RetCam wide-field infant fundus image · 640 x 480 pixels:
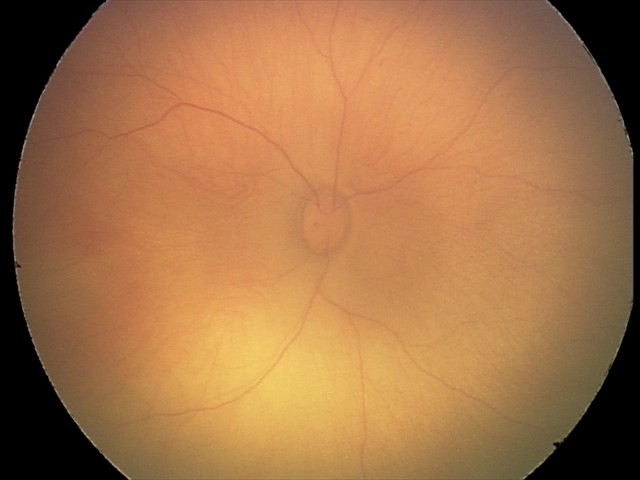
From an examination with diagnosis of retinal hemorrhages.